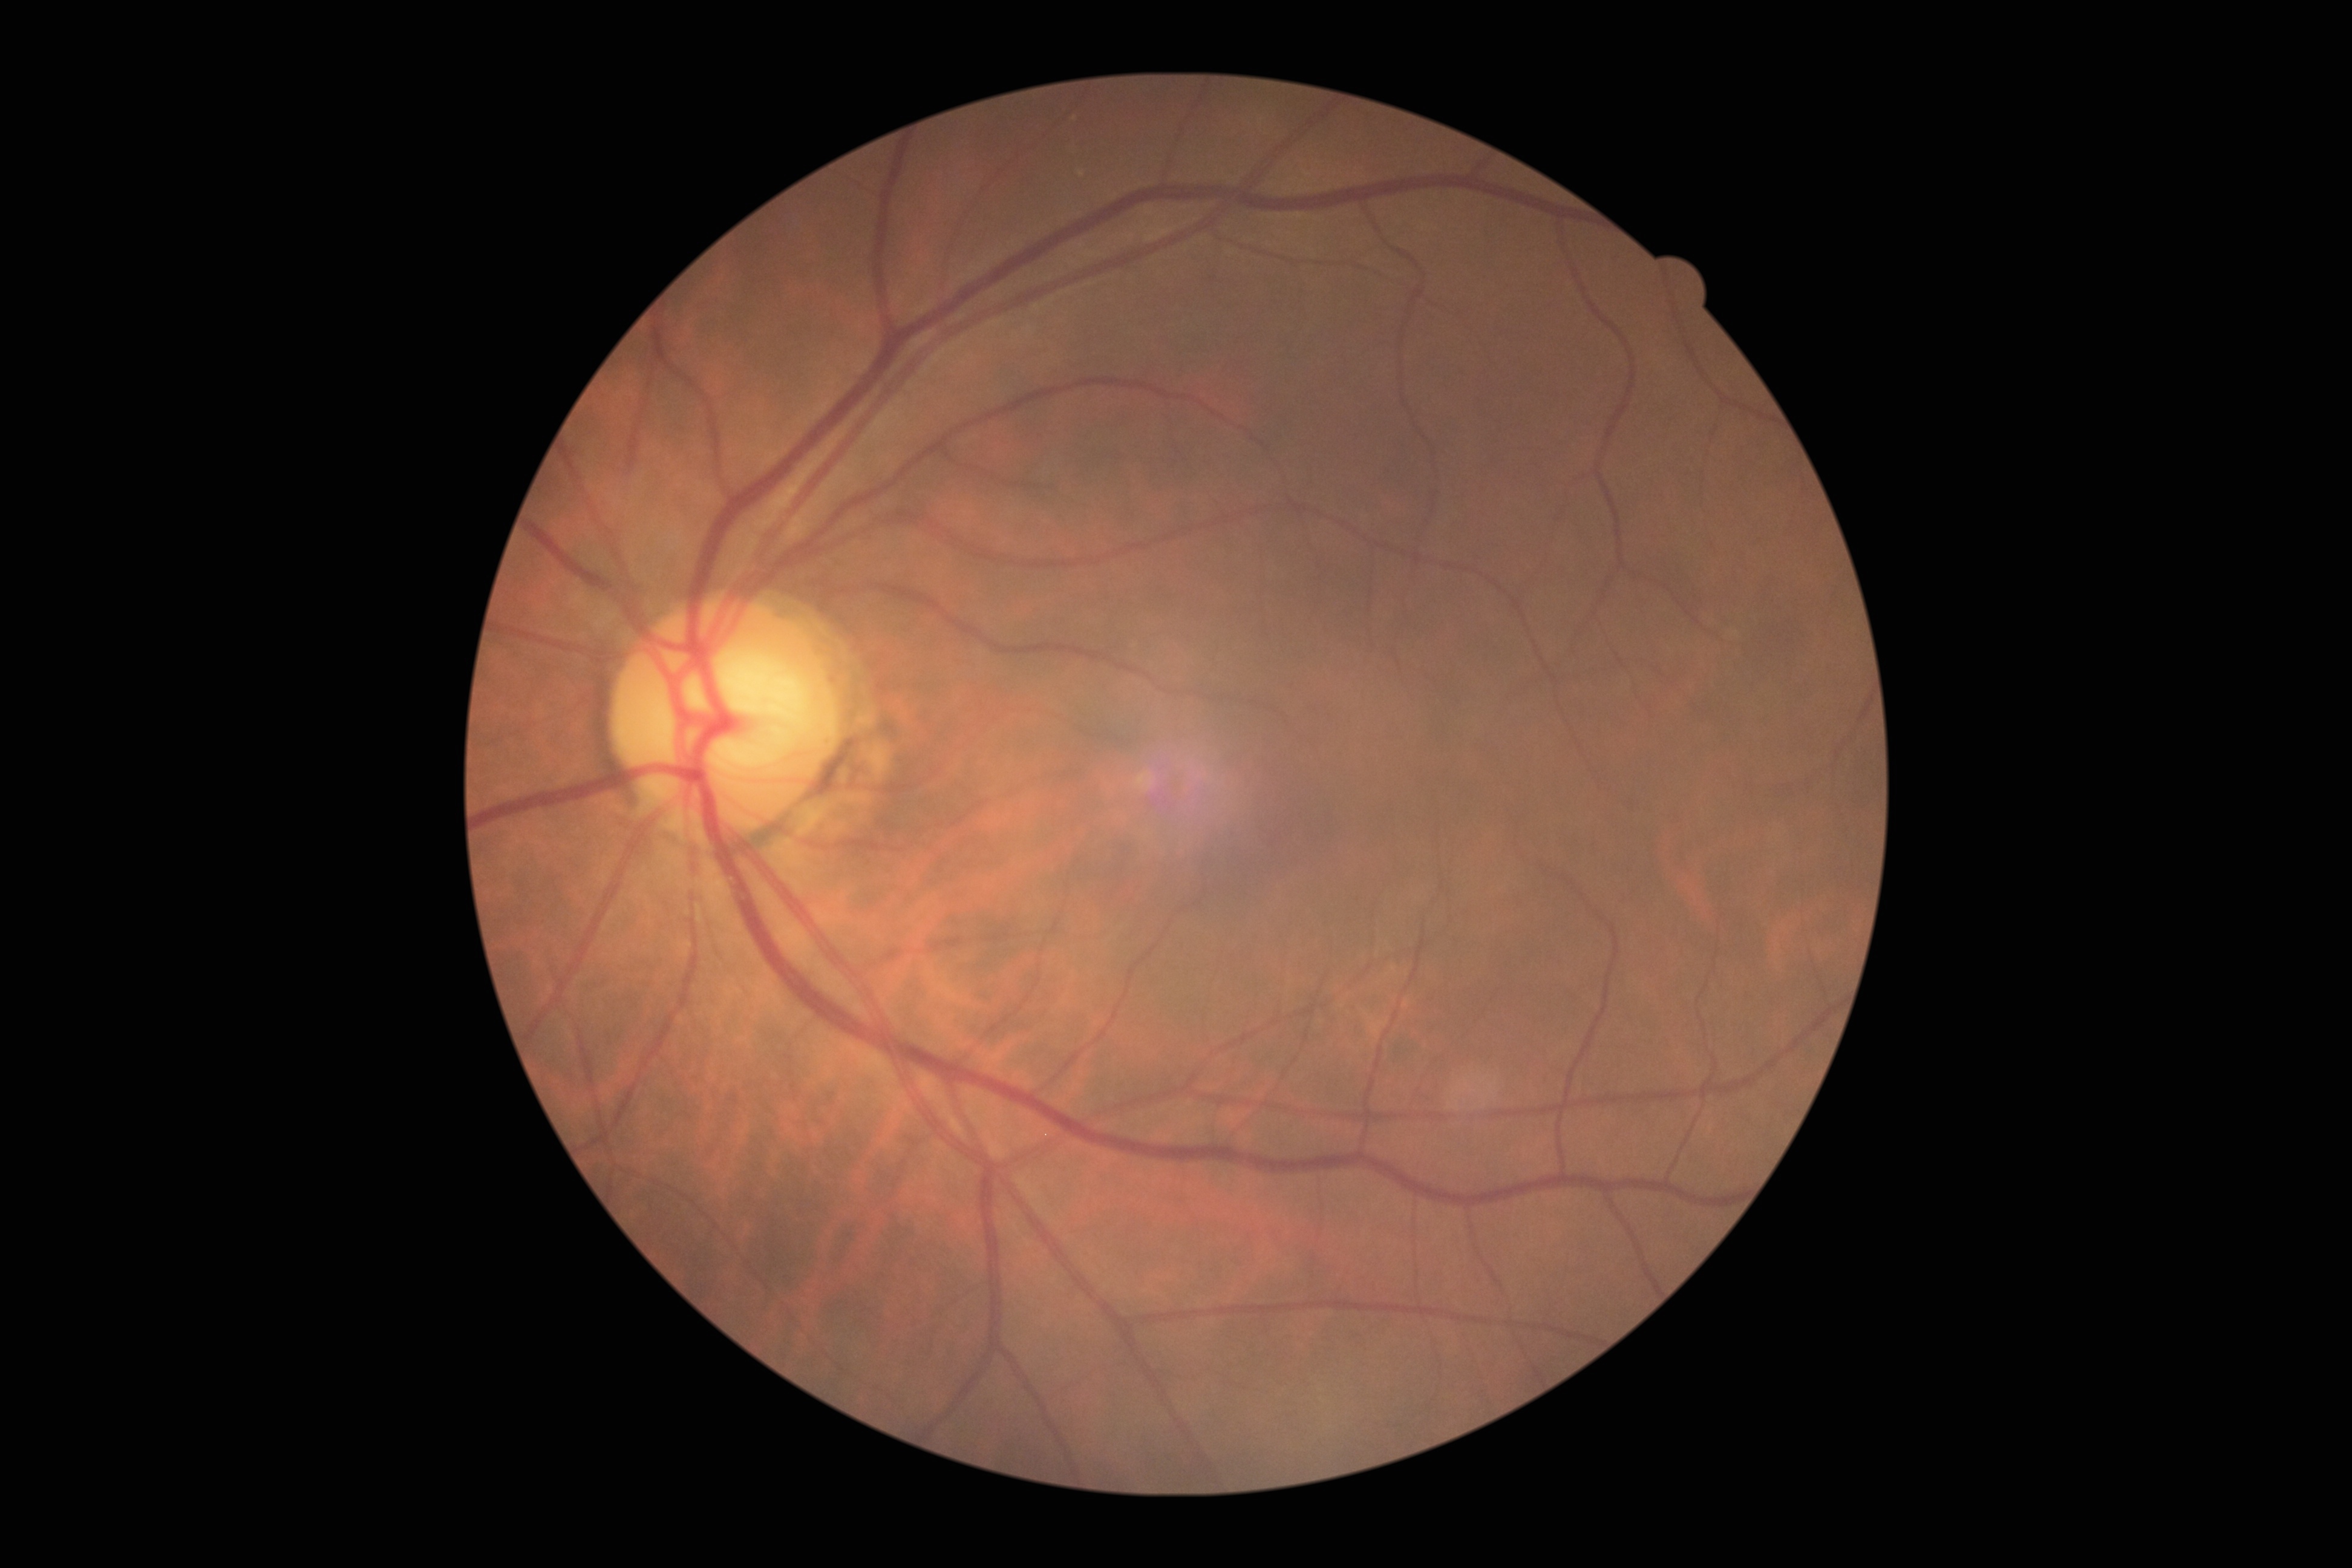

DR: grade 0 (no apparent retinopathy); DR impression: no apparent DR.